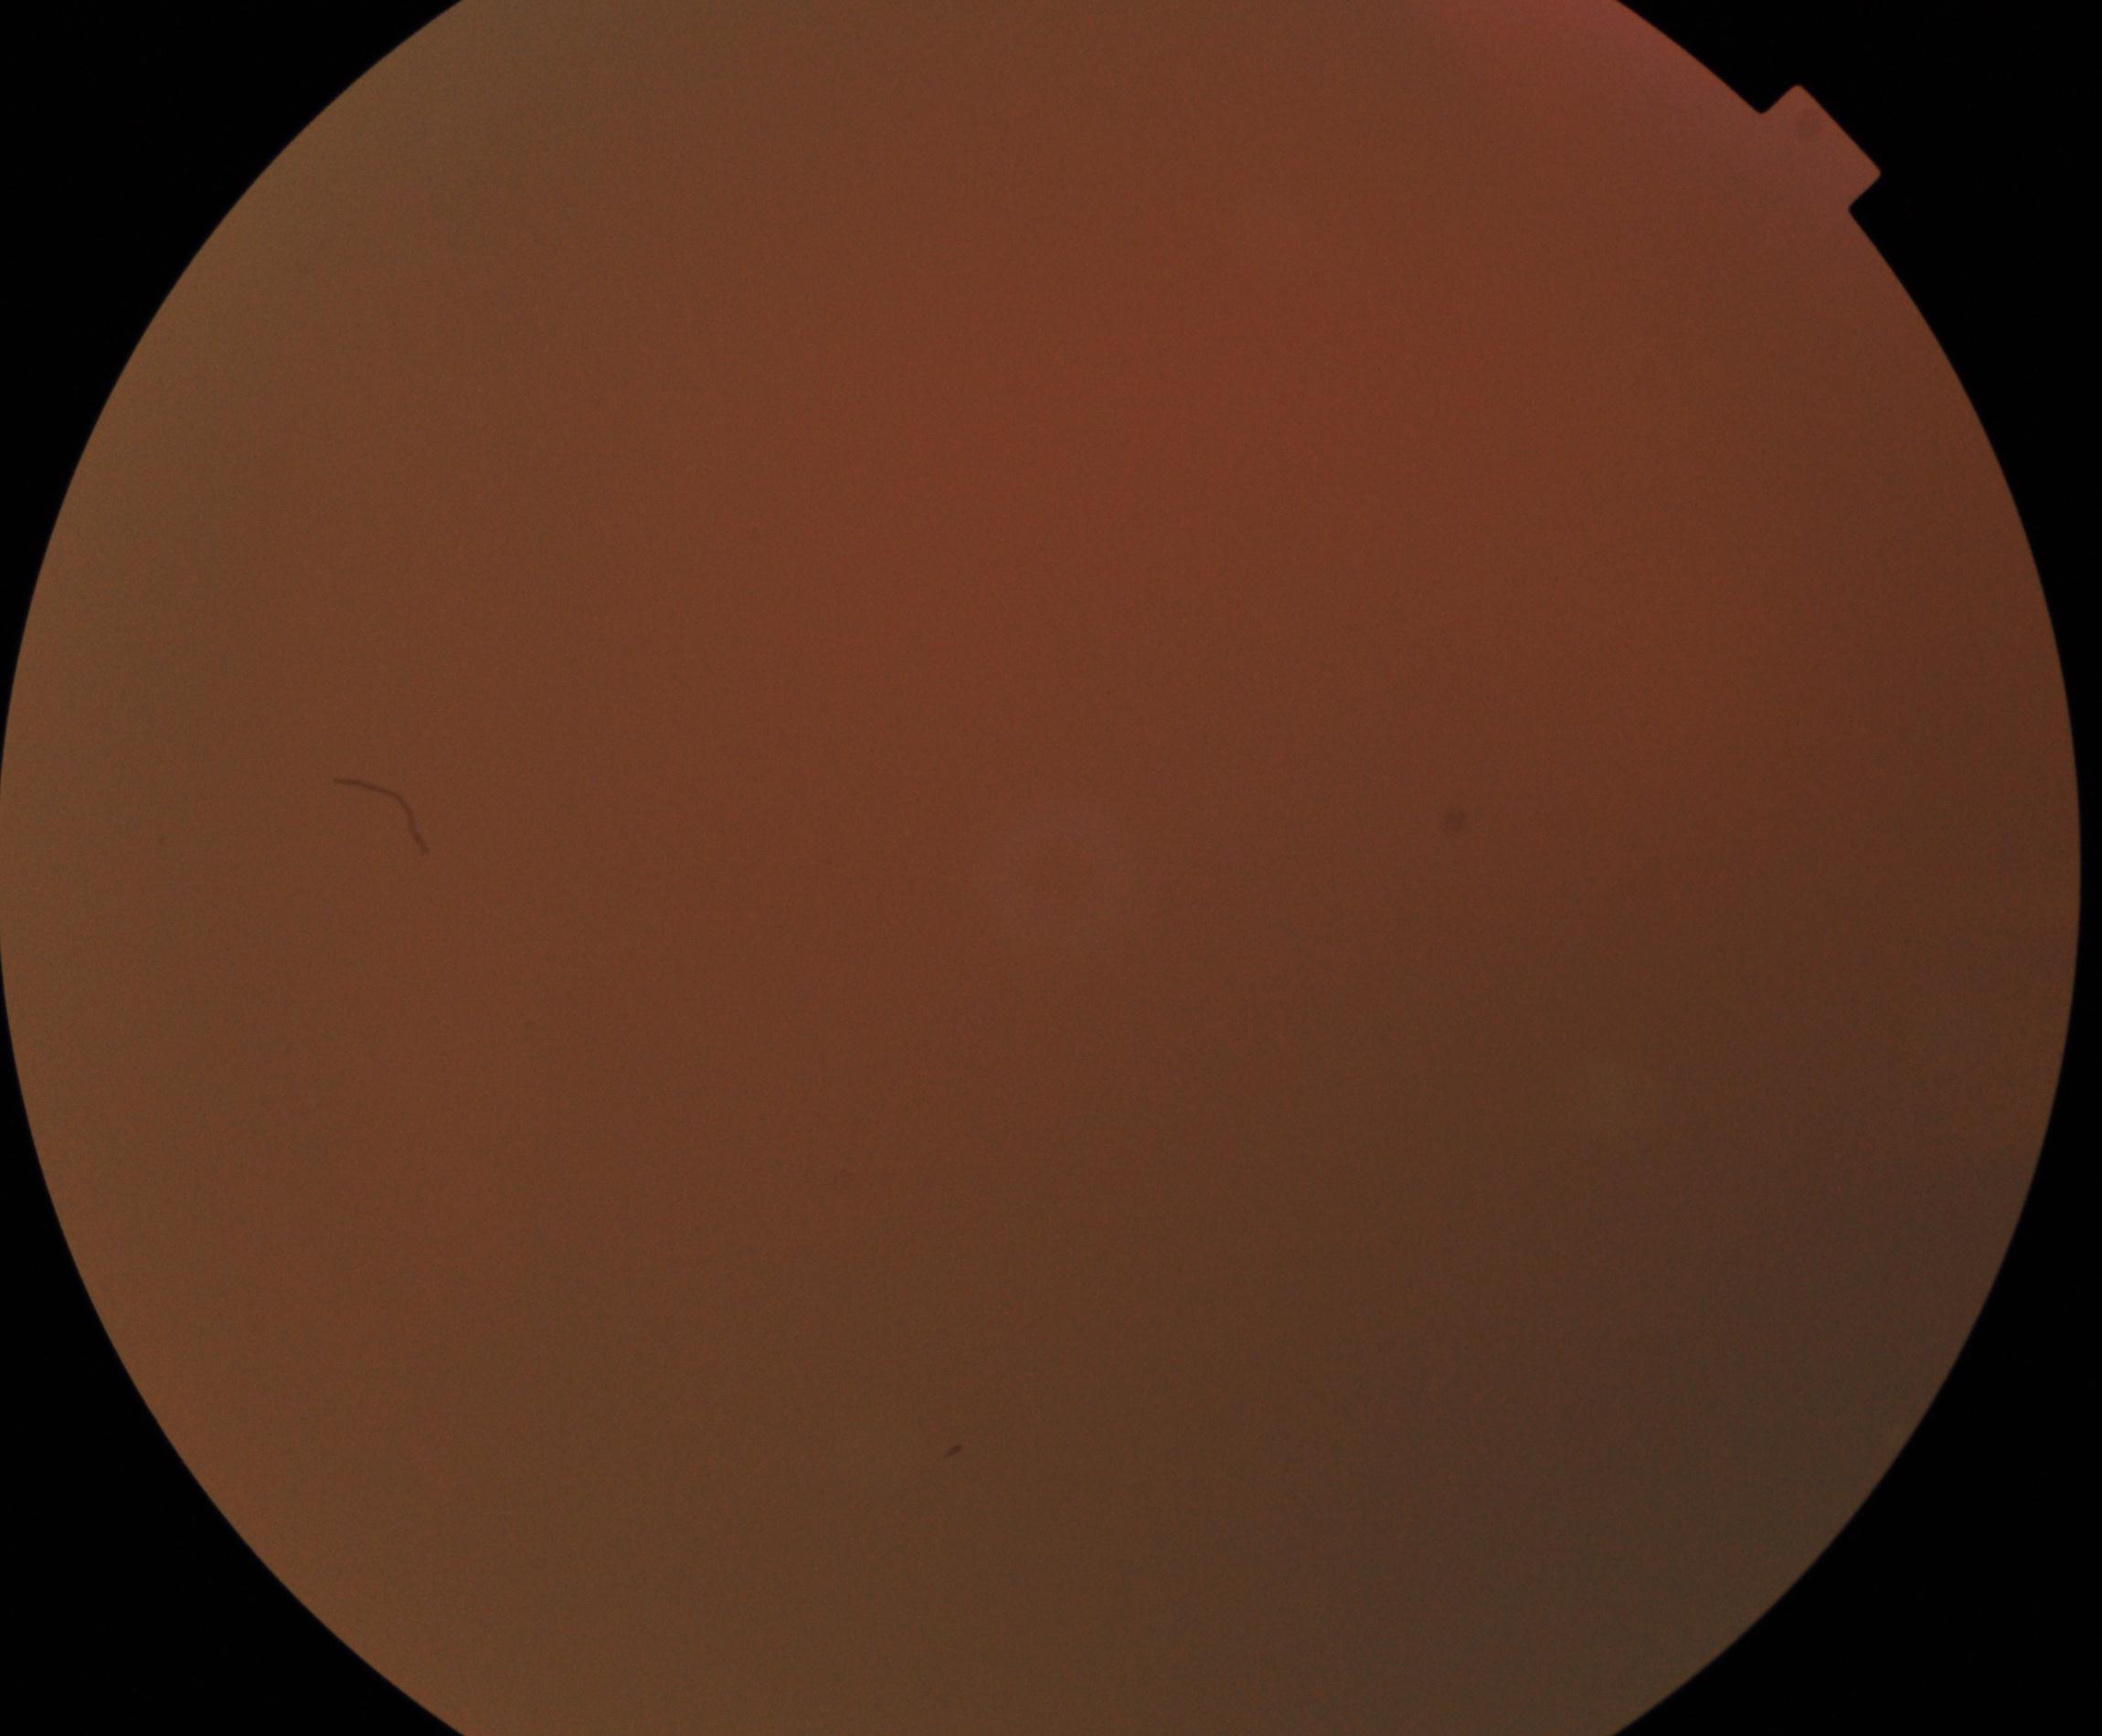
Quality: significantly degraded. Proliferative retinopathy: no evidence.